DR severity per modified Davis staging, camera: NIDEK AFC-230, nonmydriatic fundus photograph, 45° field of view.
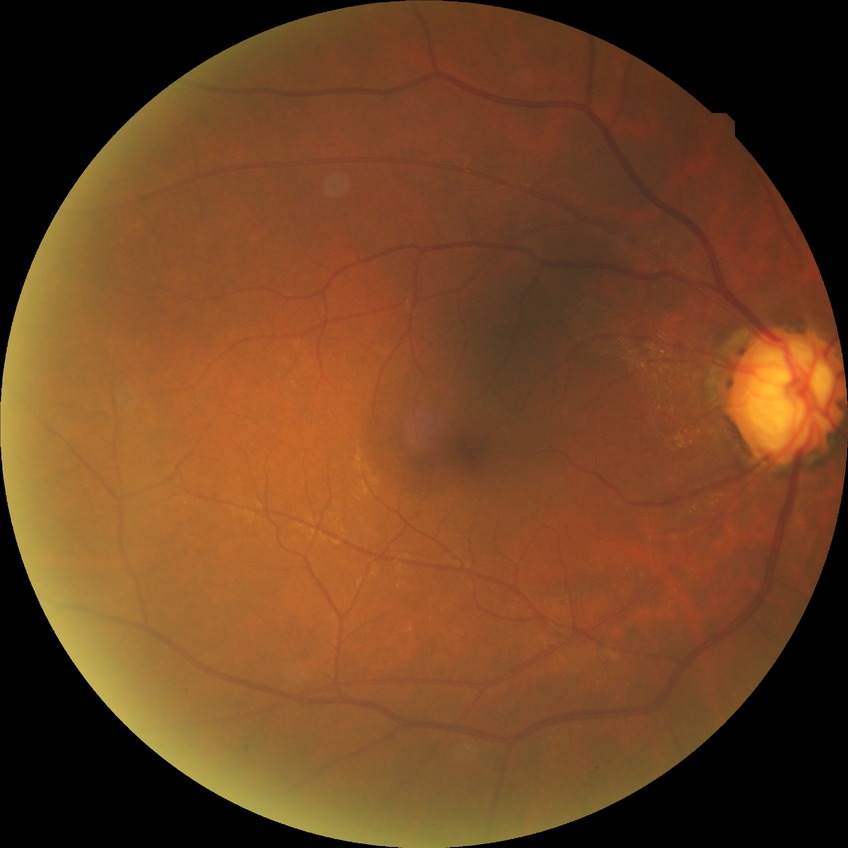
diabetic retinopathy (DR): SDR (simple diabetic retinopathy).